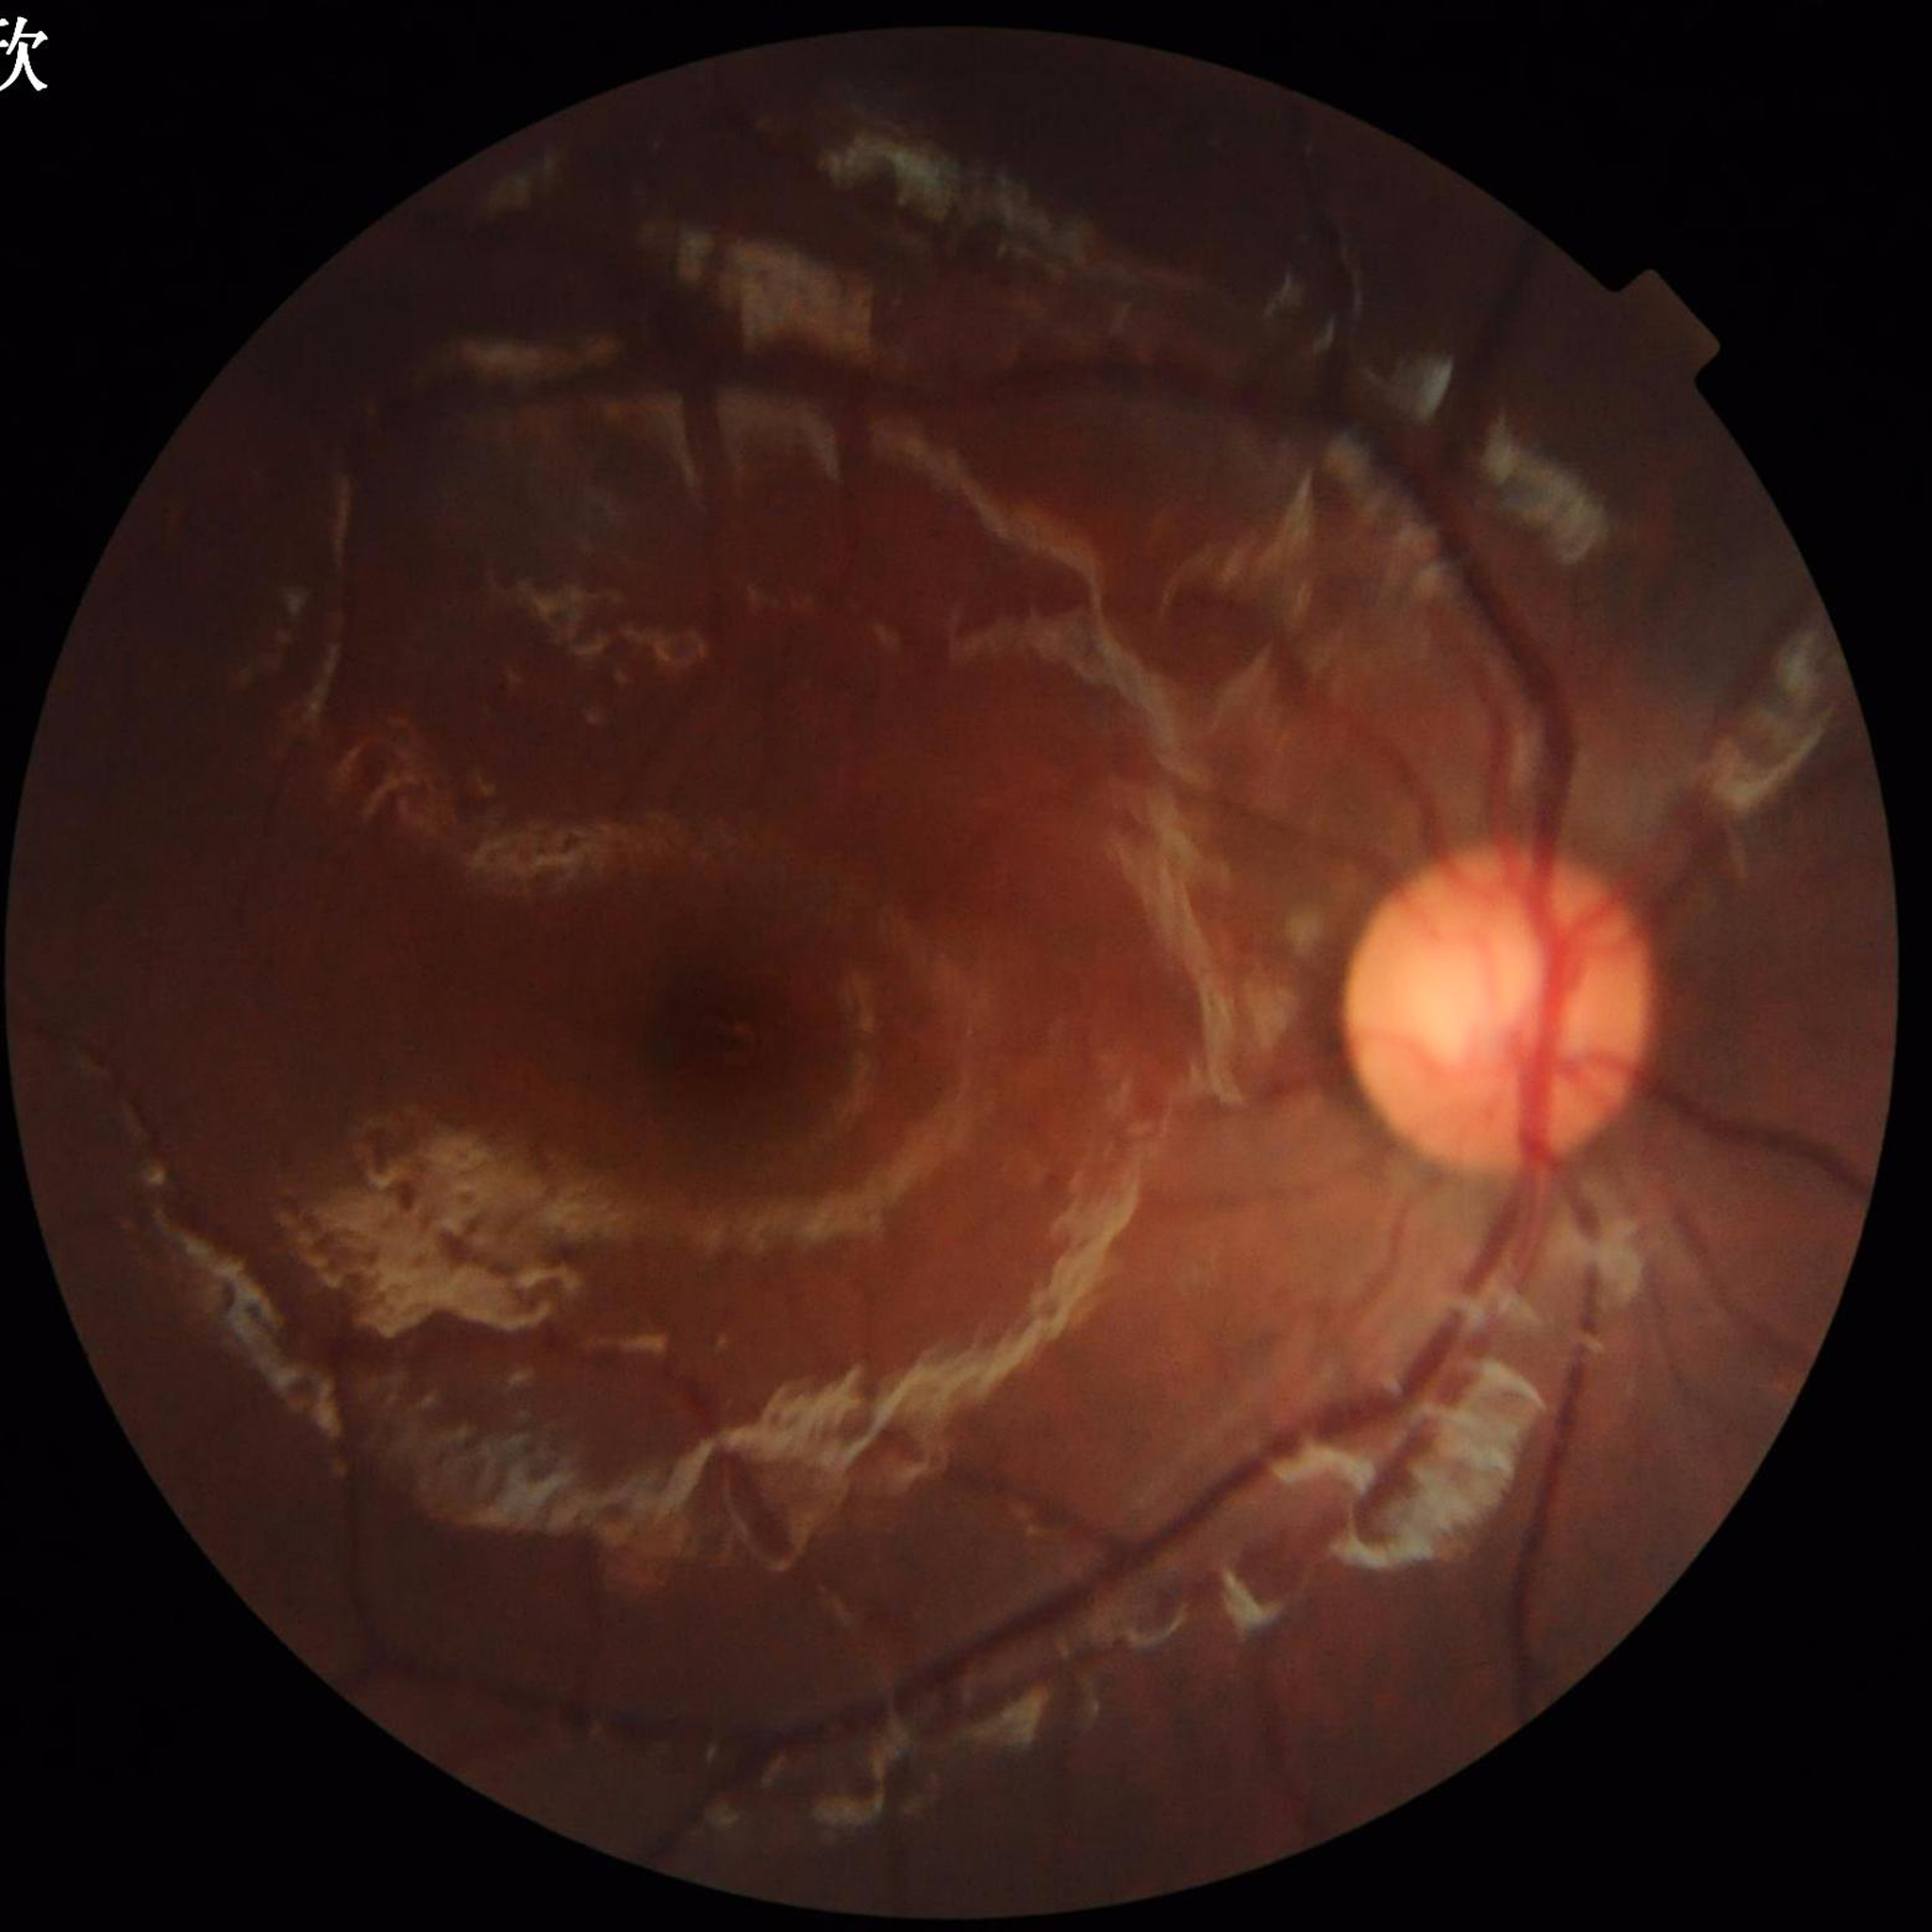
{"diagnosis": "no AMD, DR, or glaucomatous findings"}